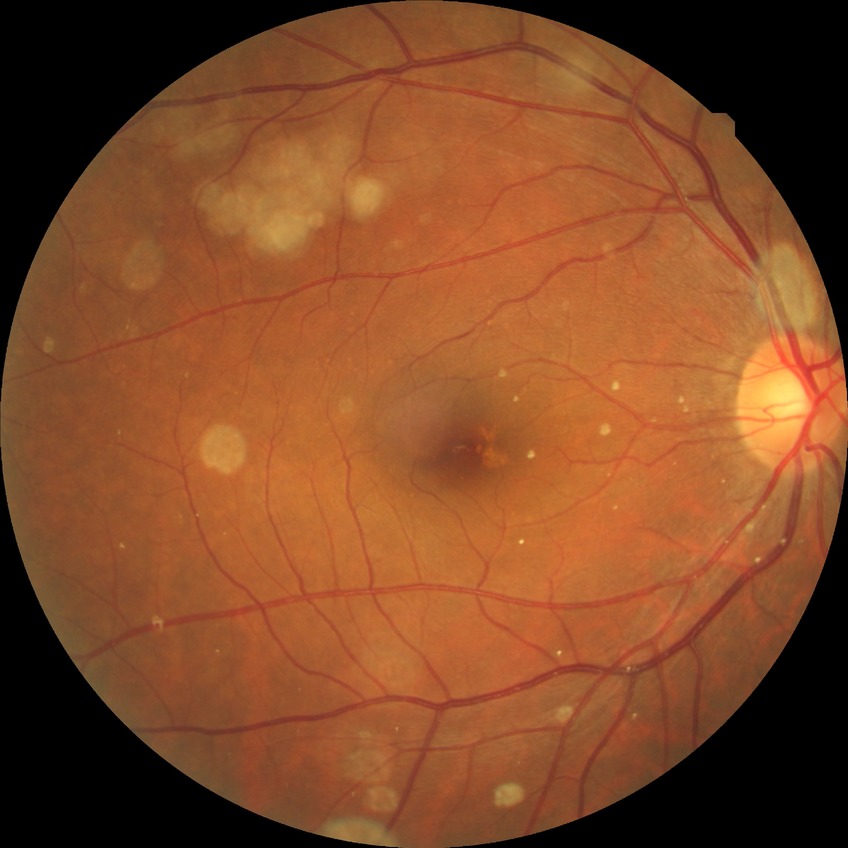
modified Davis classification: no diabetic retinopathy.